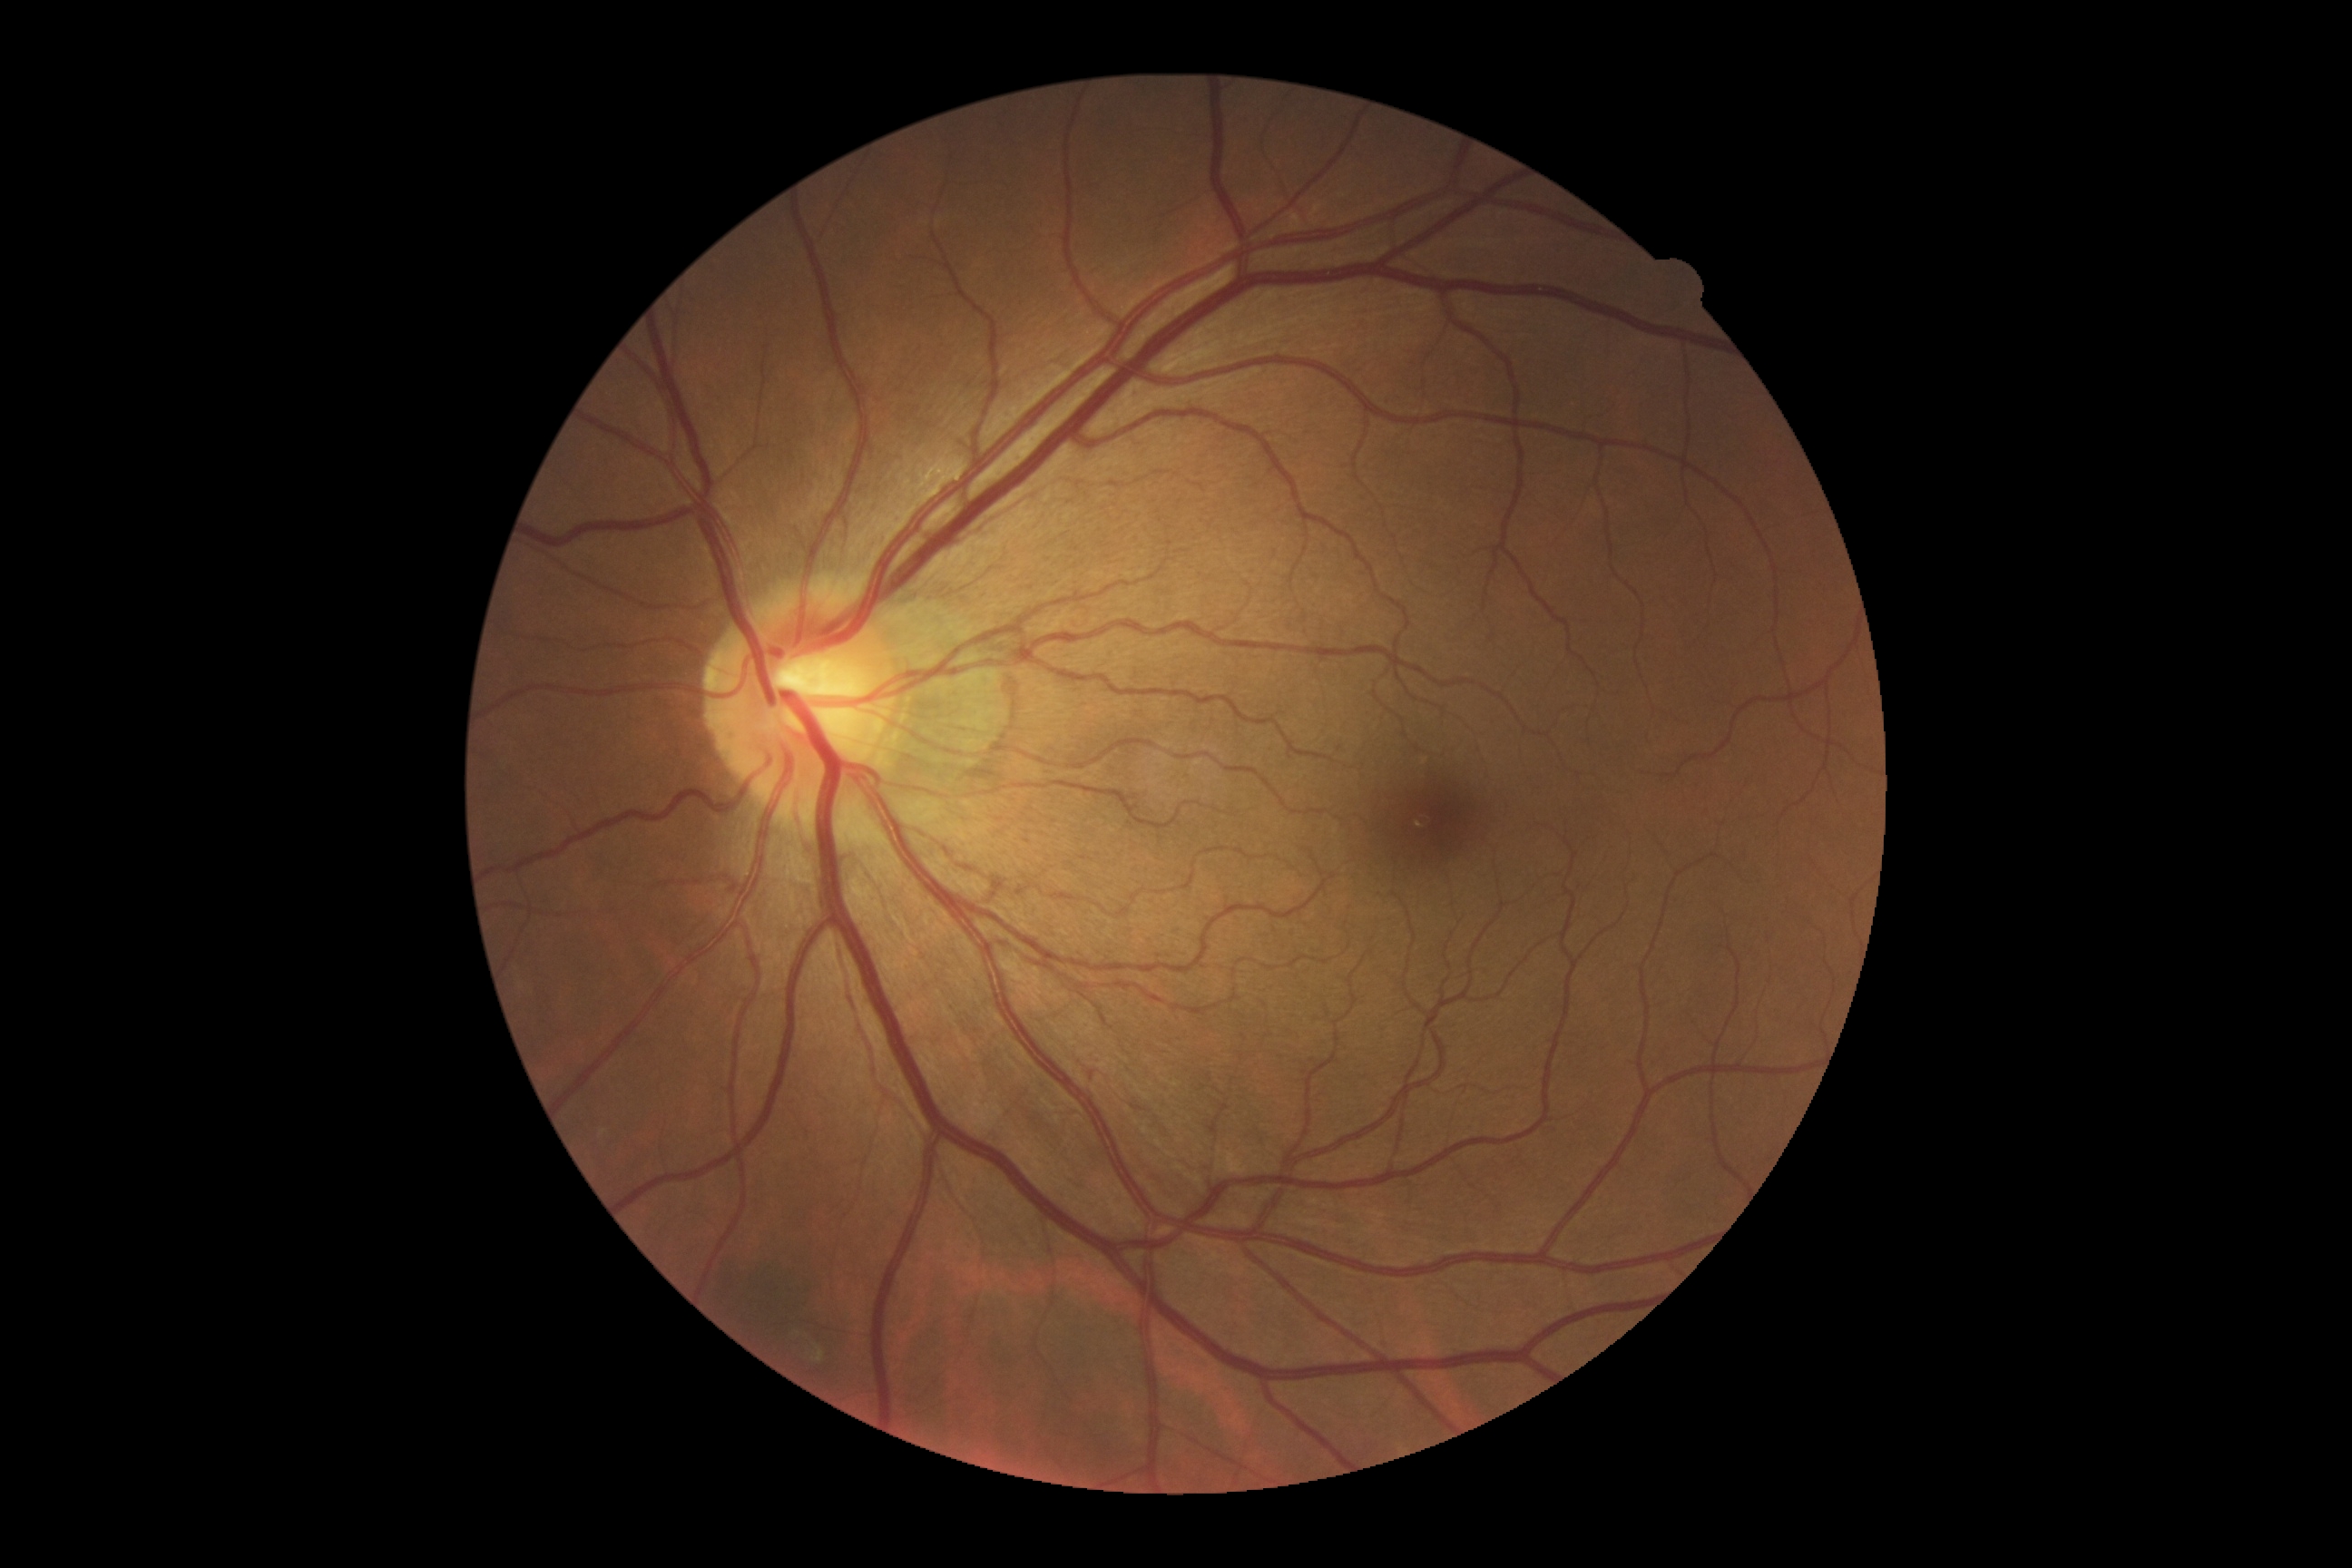
Annotations:
– DR impression: no signs of DR
– DR: 0 — no visible signs of diabetic retinopathy